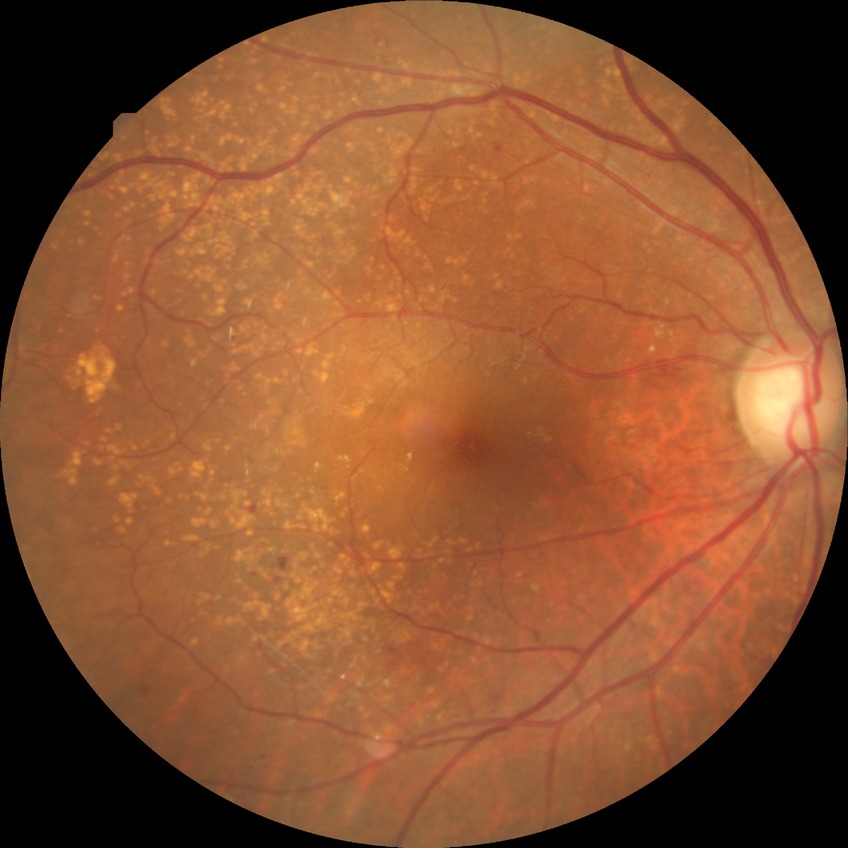 DR class: non-proliferative diabetic retinopathy
diabetic retinopathy (DR): simple diabetic retinopathy (SDR)